Pediatric wide-field fundus photograph; 640 x 480 pixels.
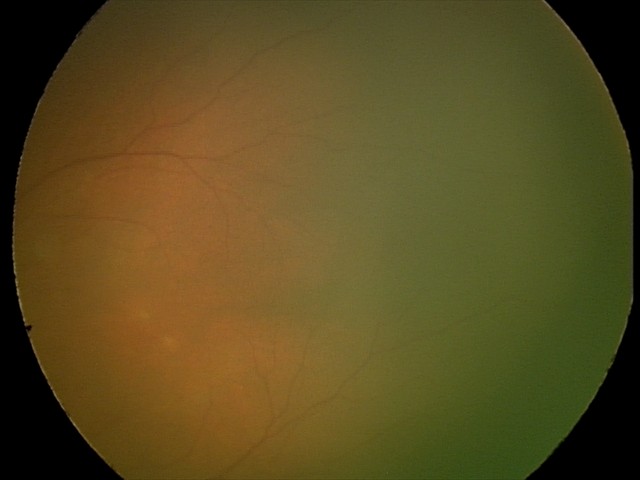 Examination with physiological retinal findings.